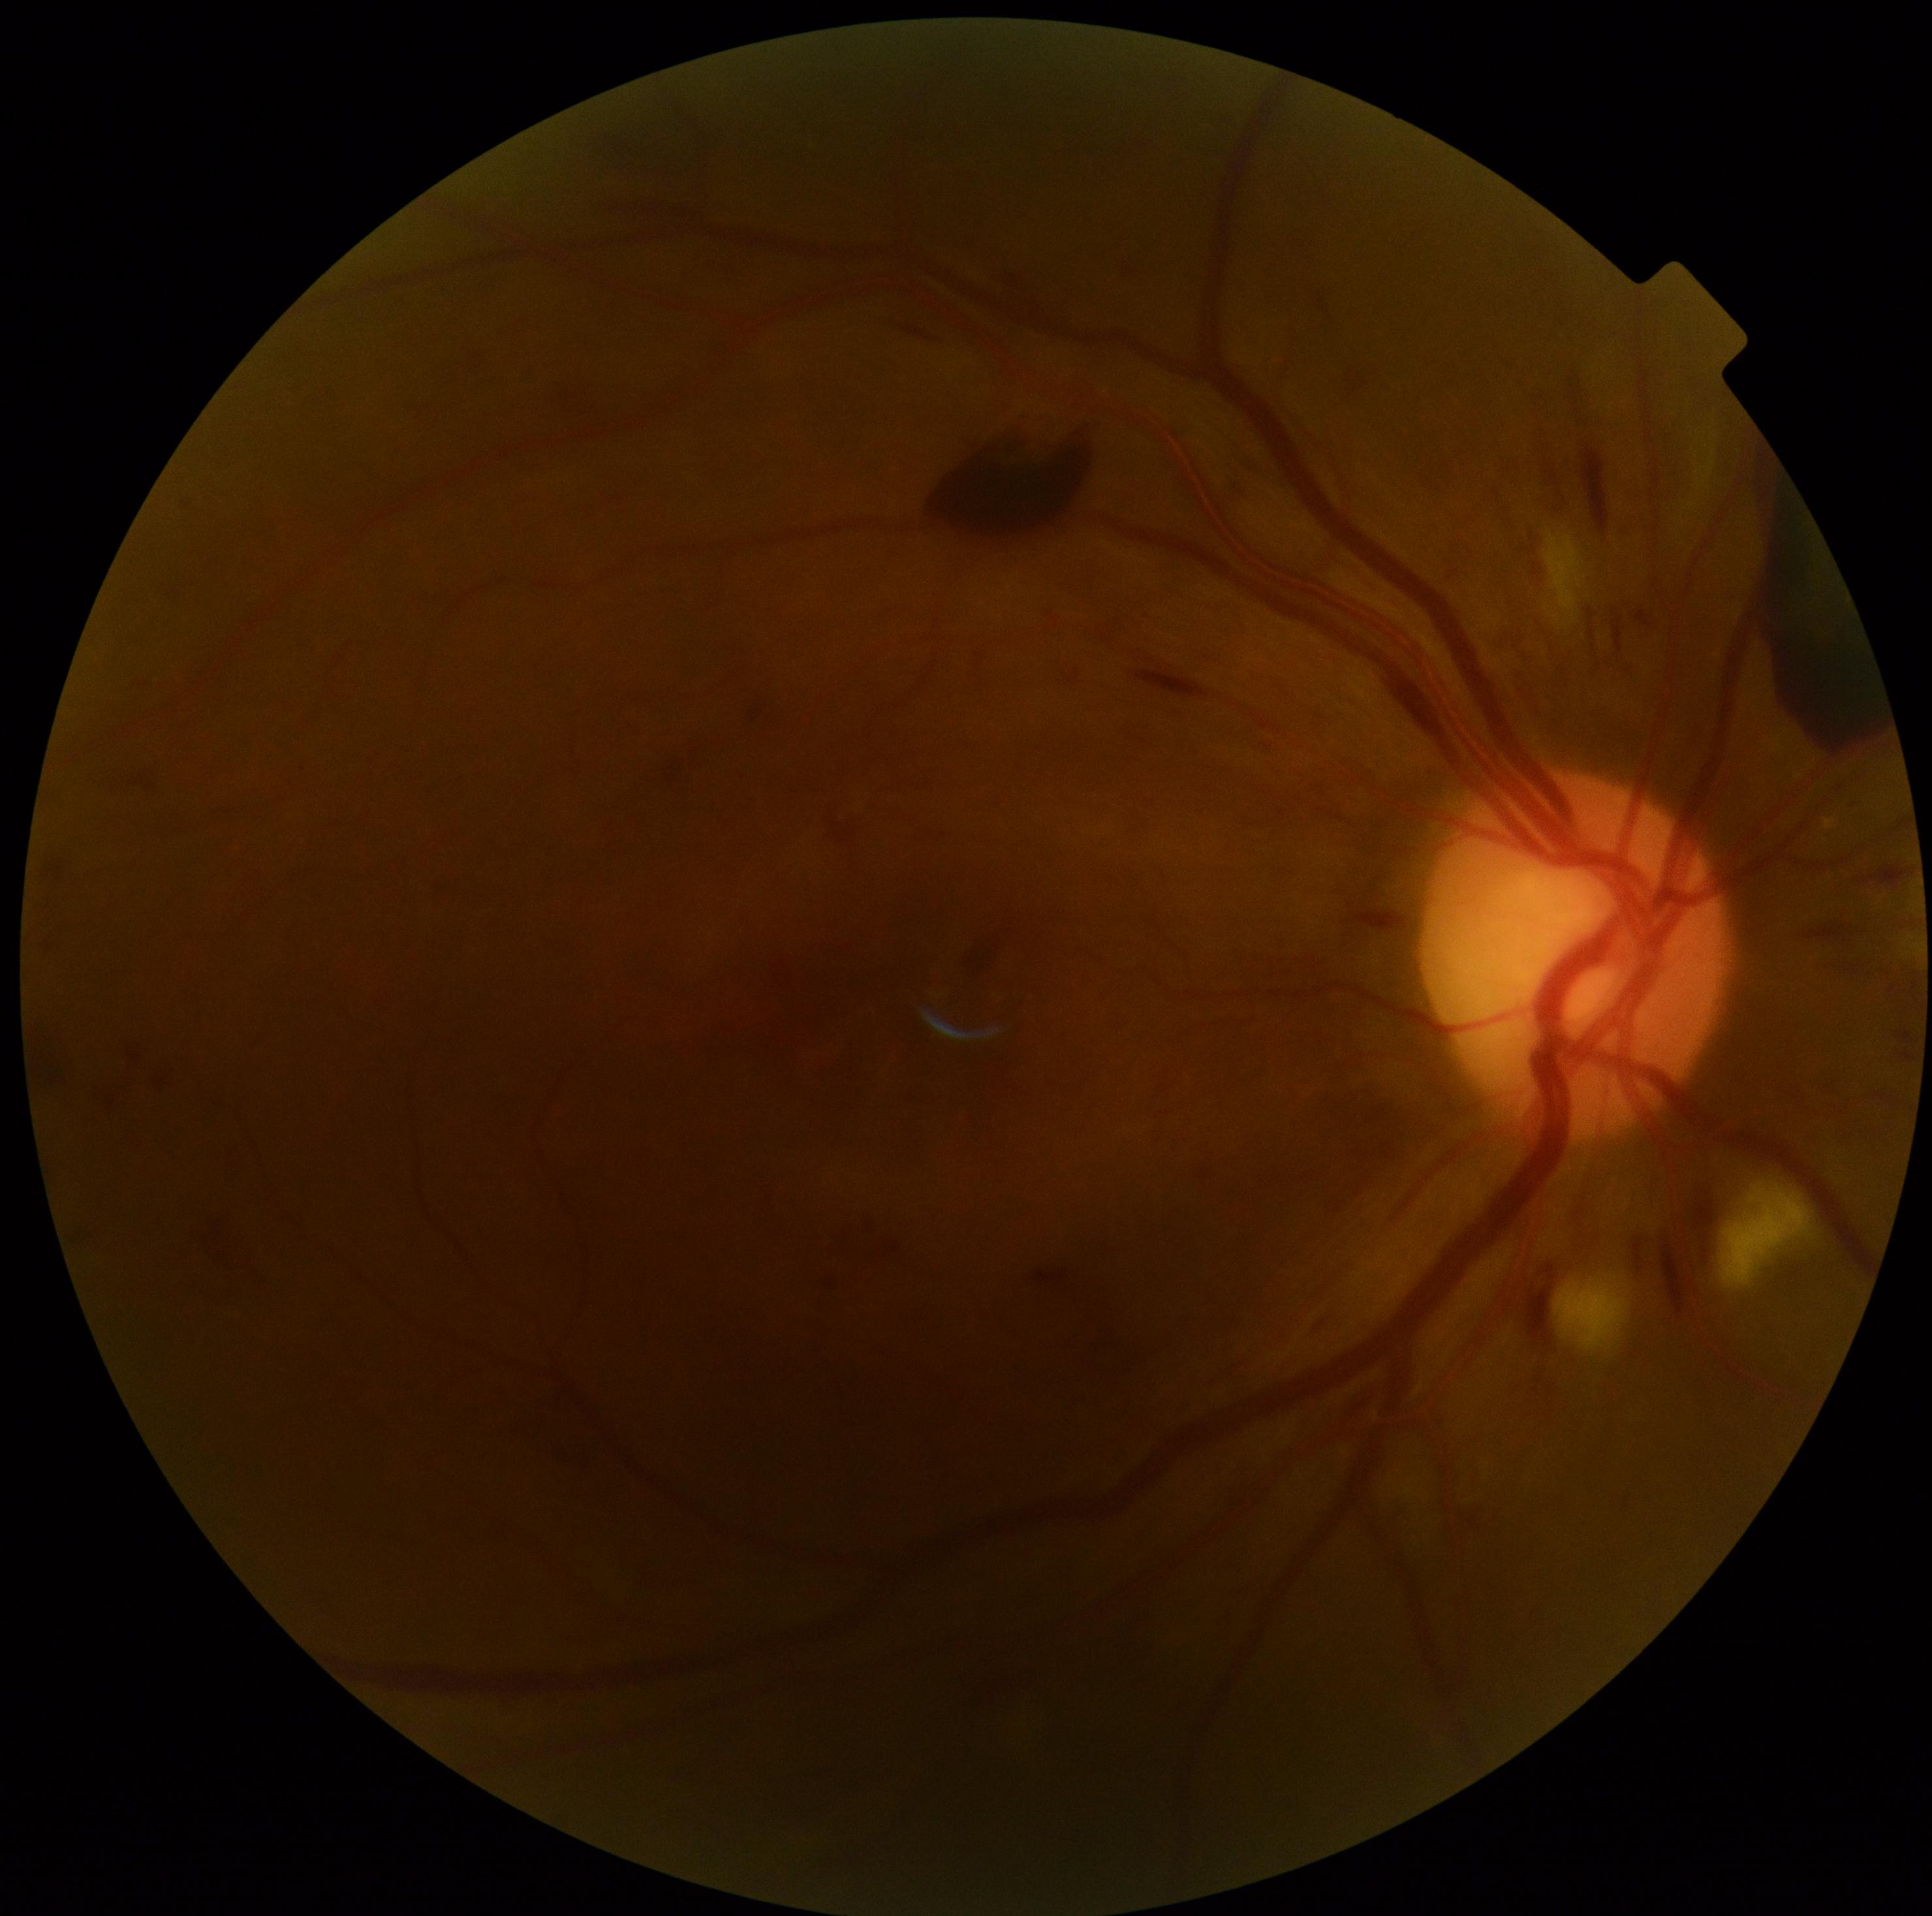 DR grade: PDR (4)